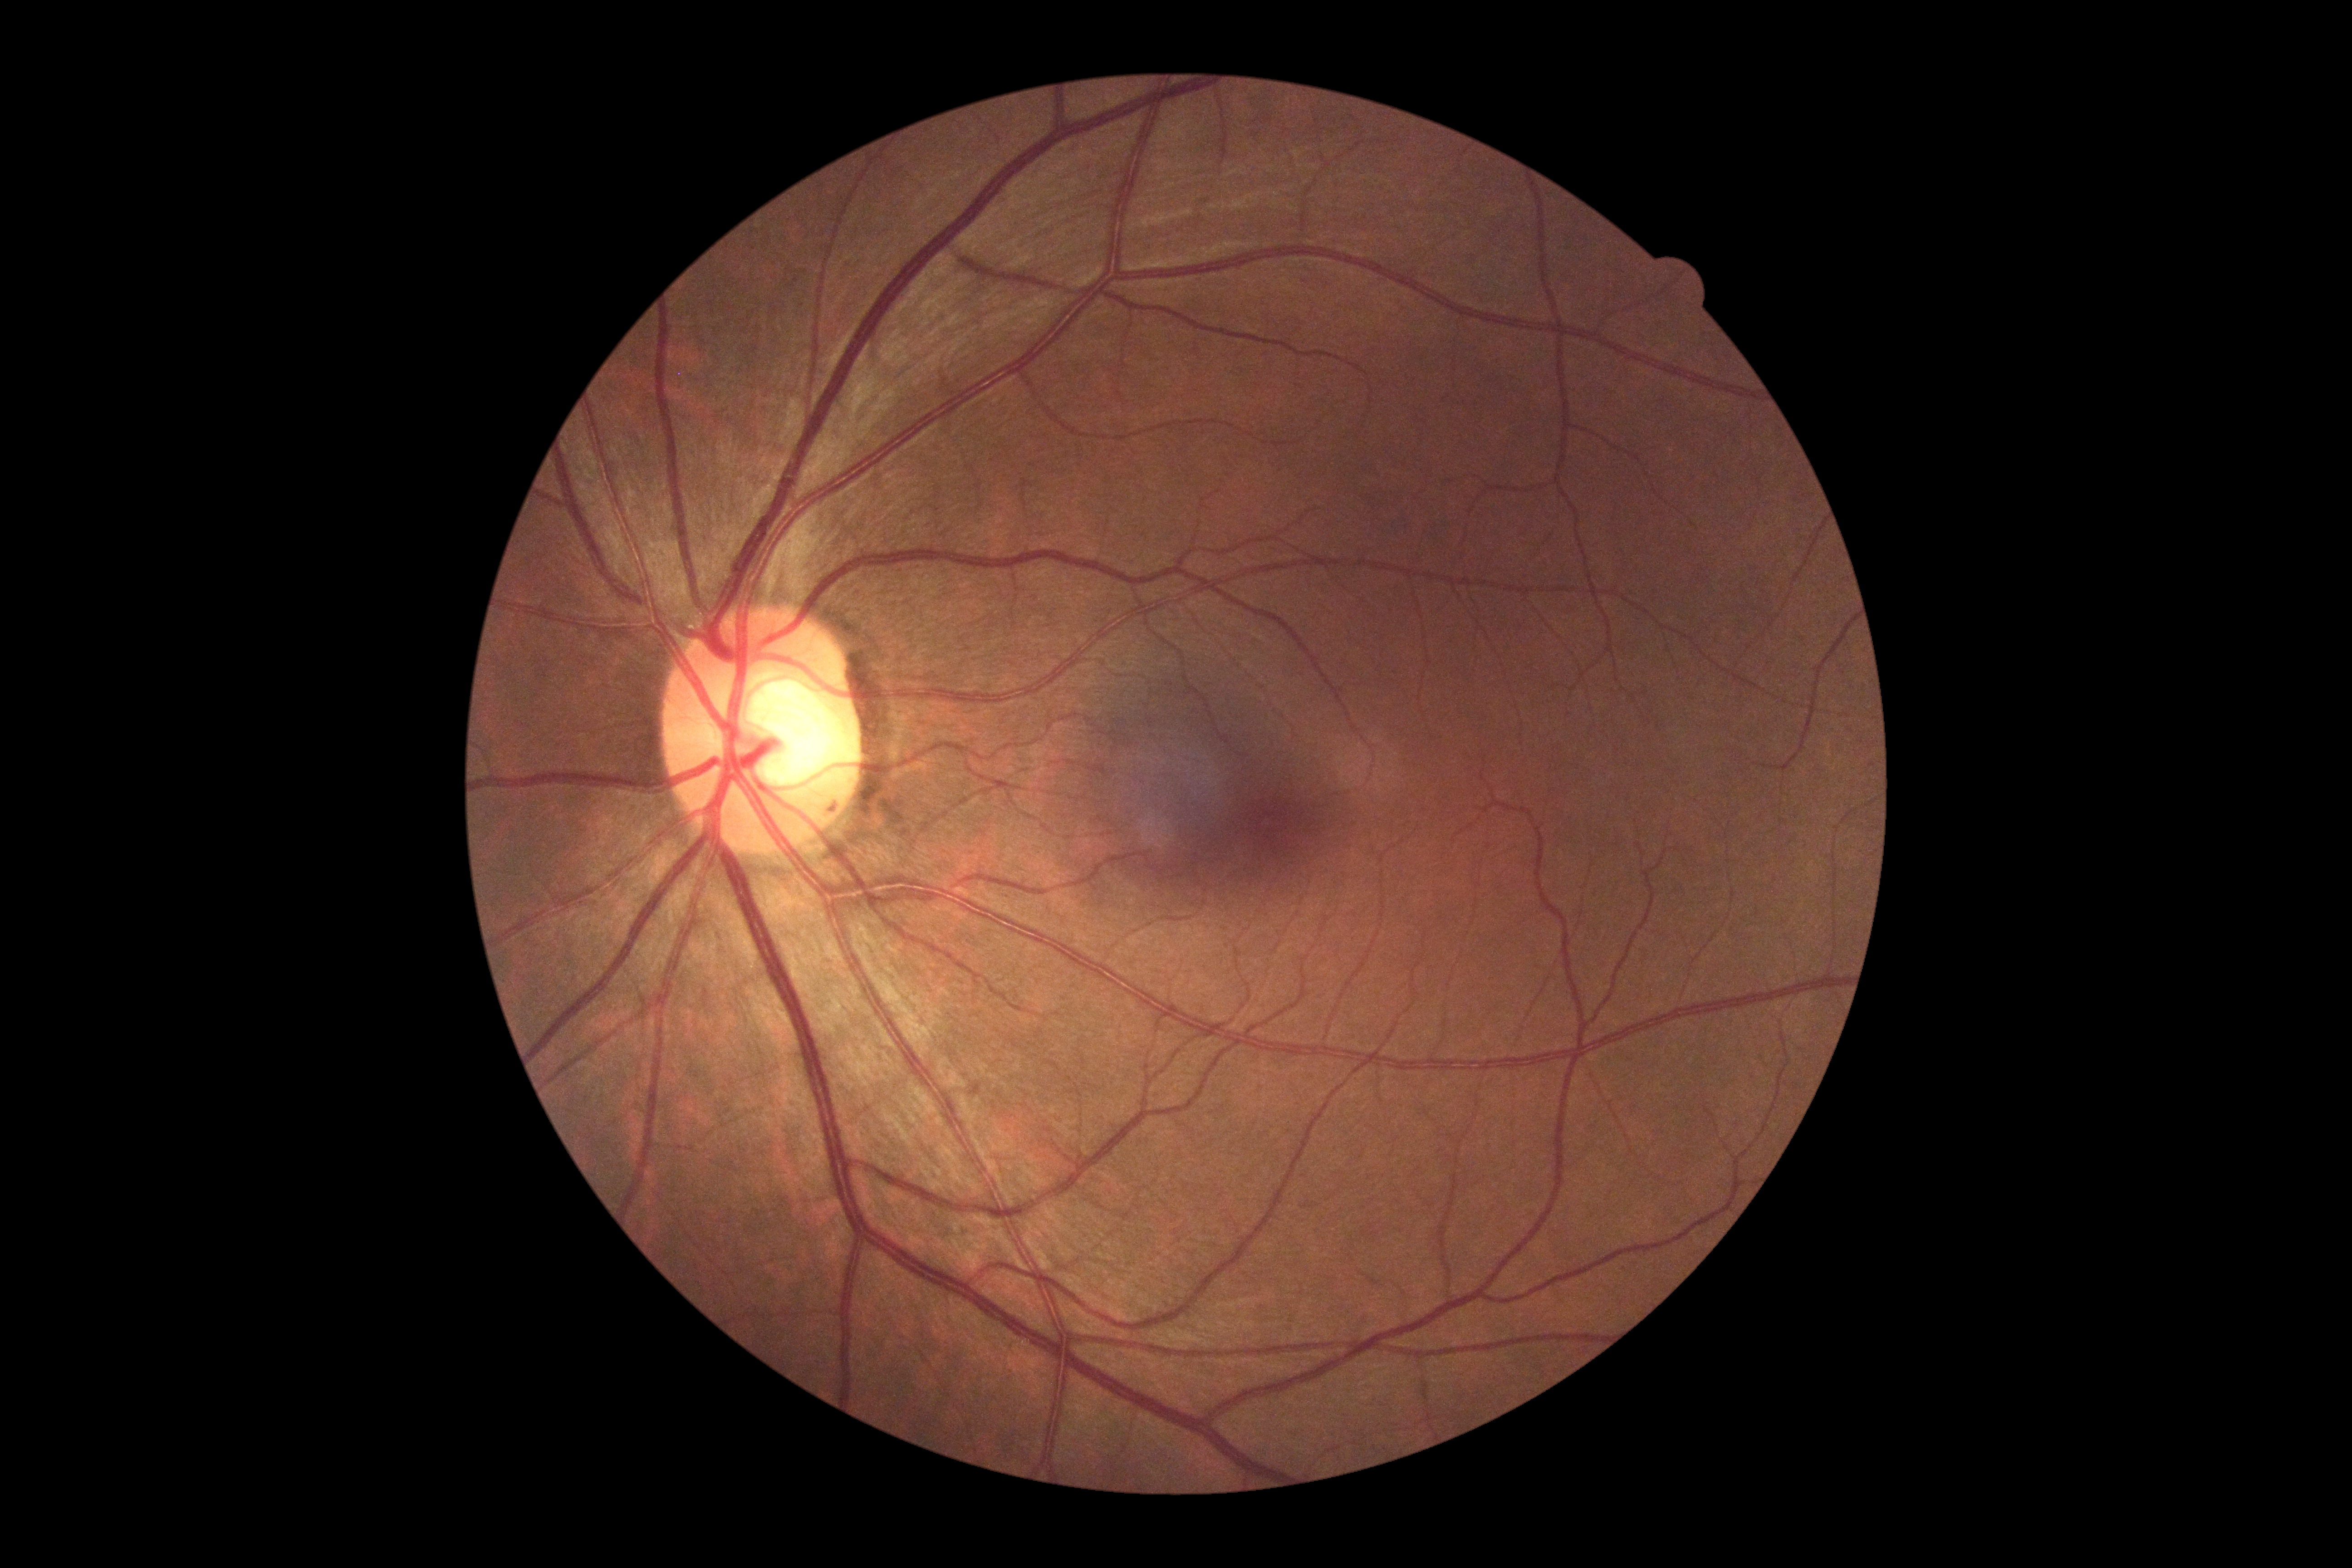
No signs of diabetic retinopathy. Diabetic retinopathy: 0.